2352 x 1568 pixels; 45-degree field of view; color fundus image — 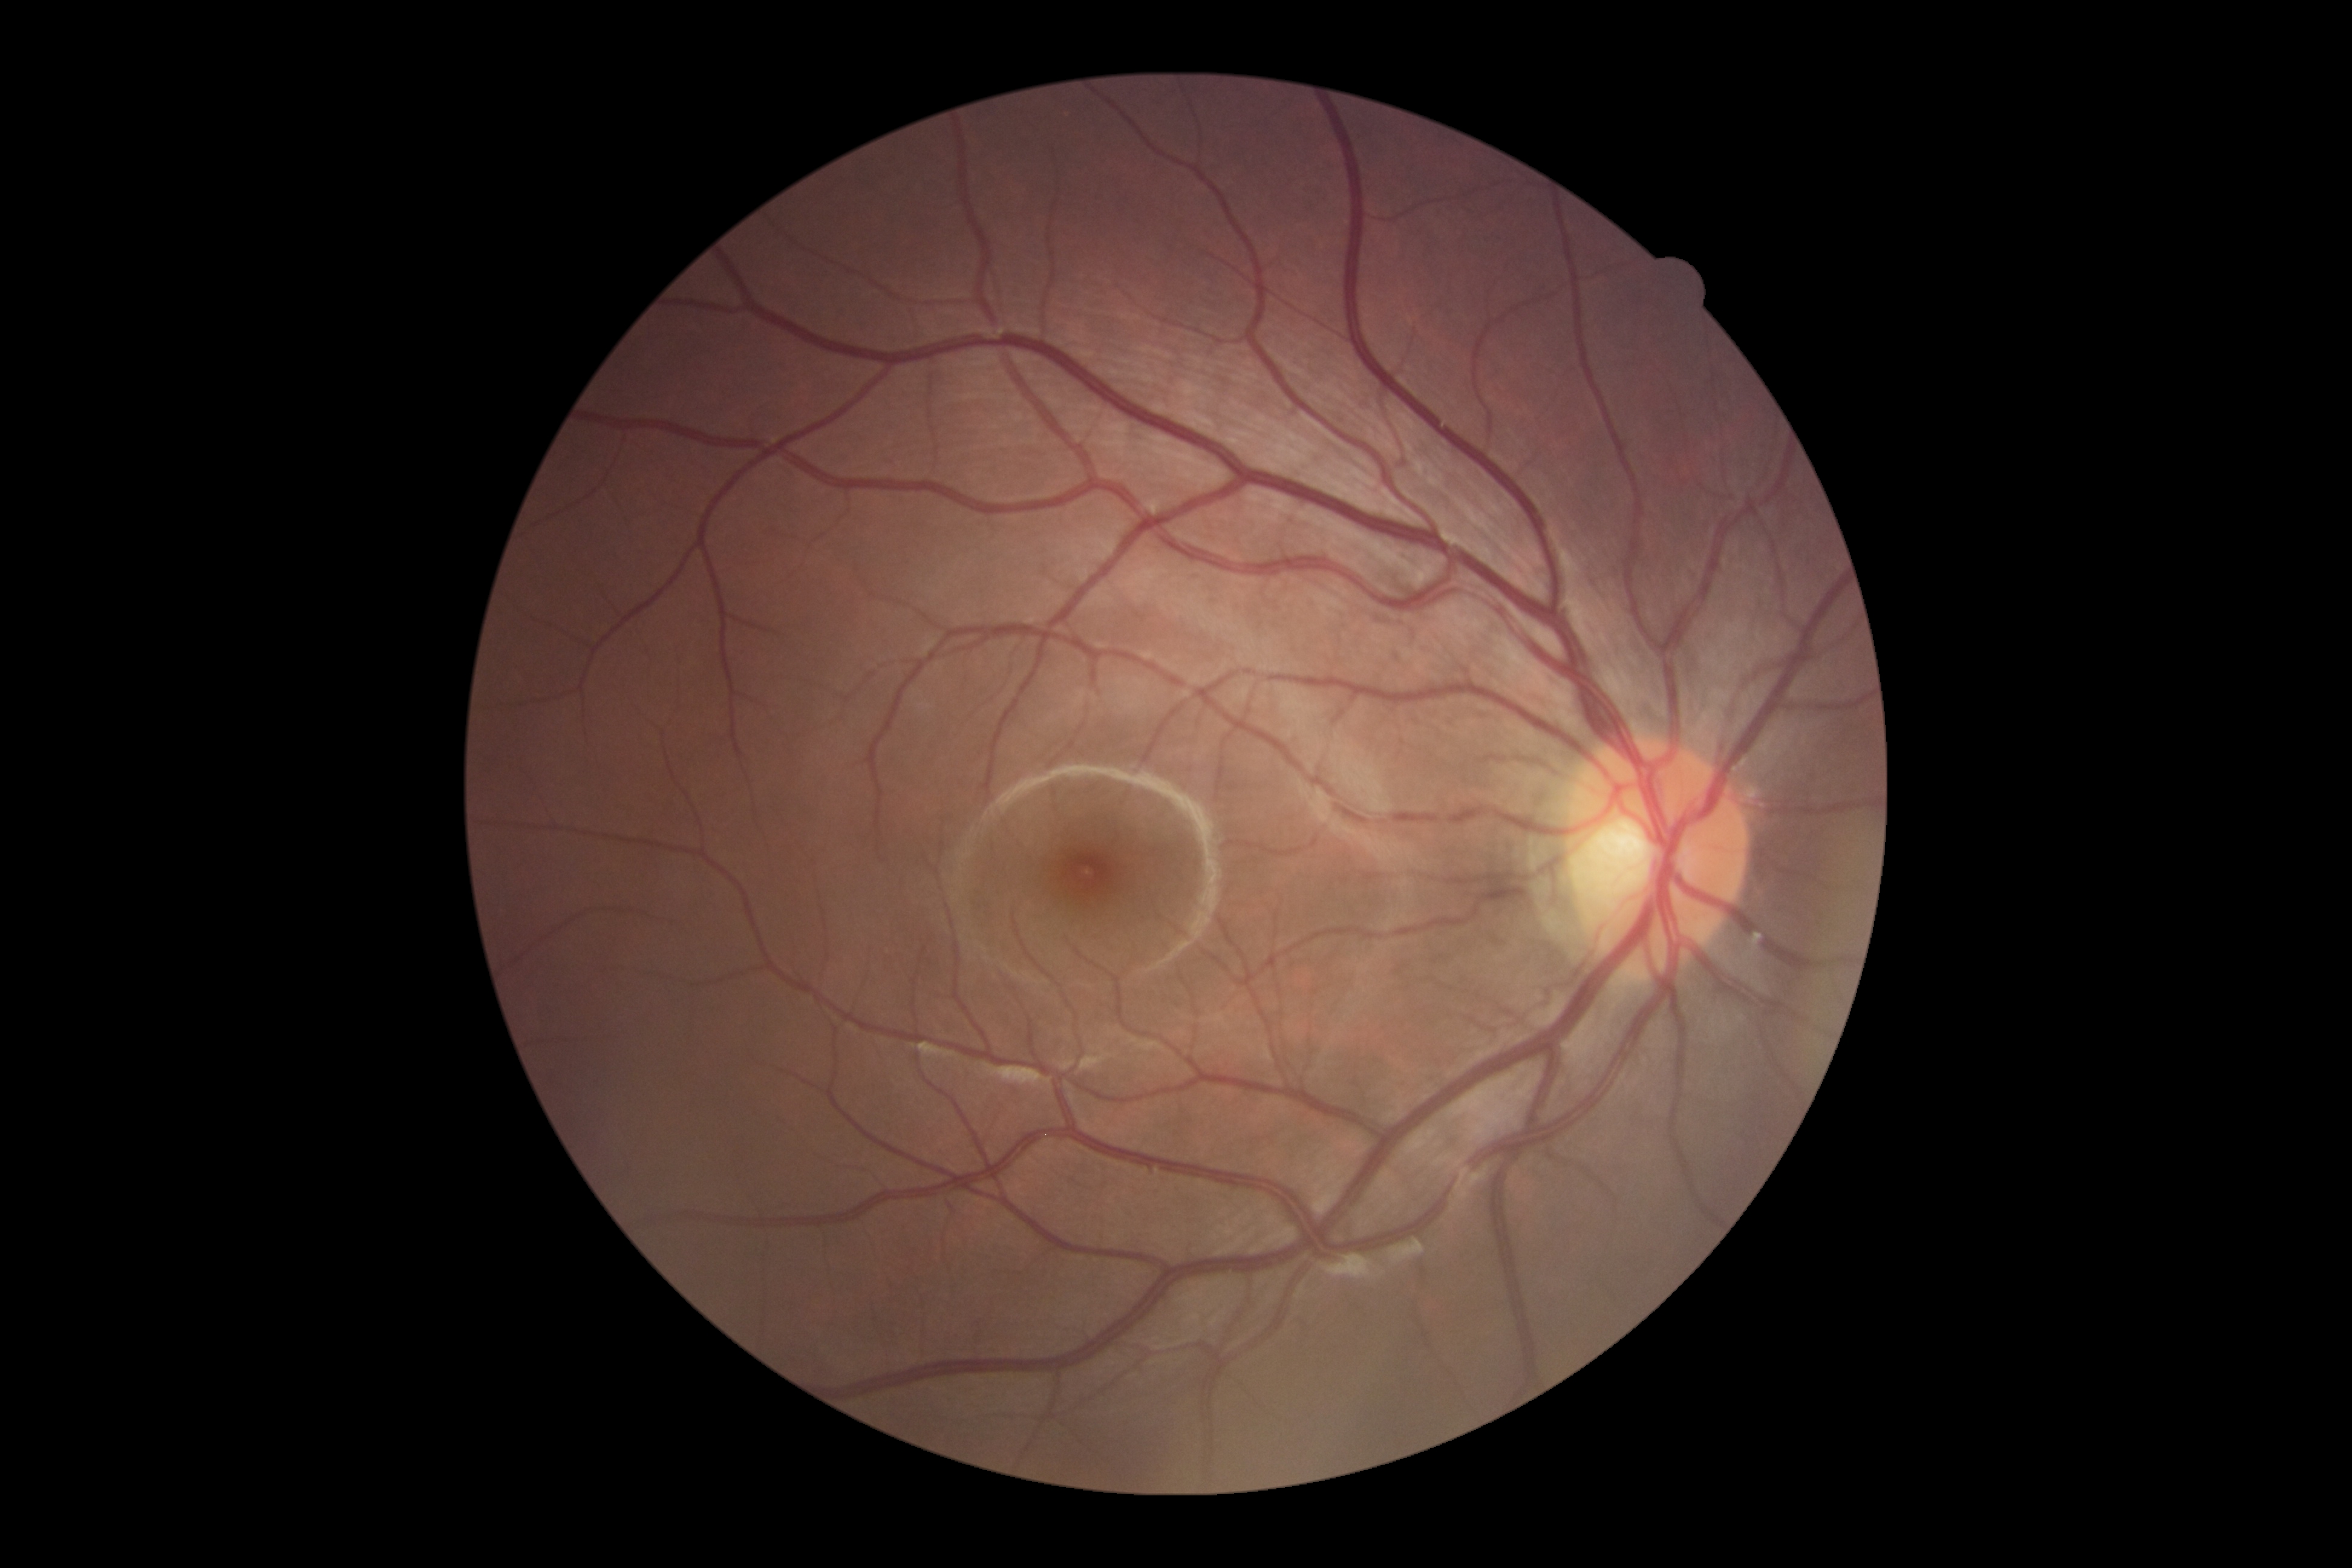
No DR findings.
Diabetic retinopathy (DR) is no apparent diabetic retinopathy (grade 0).